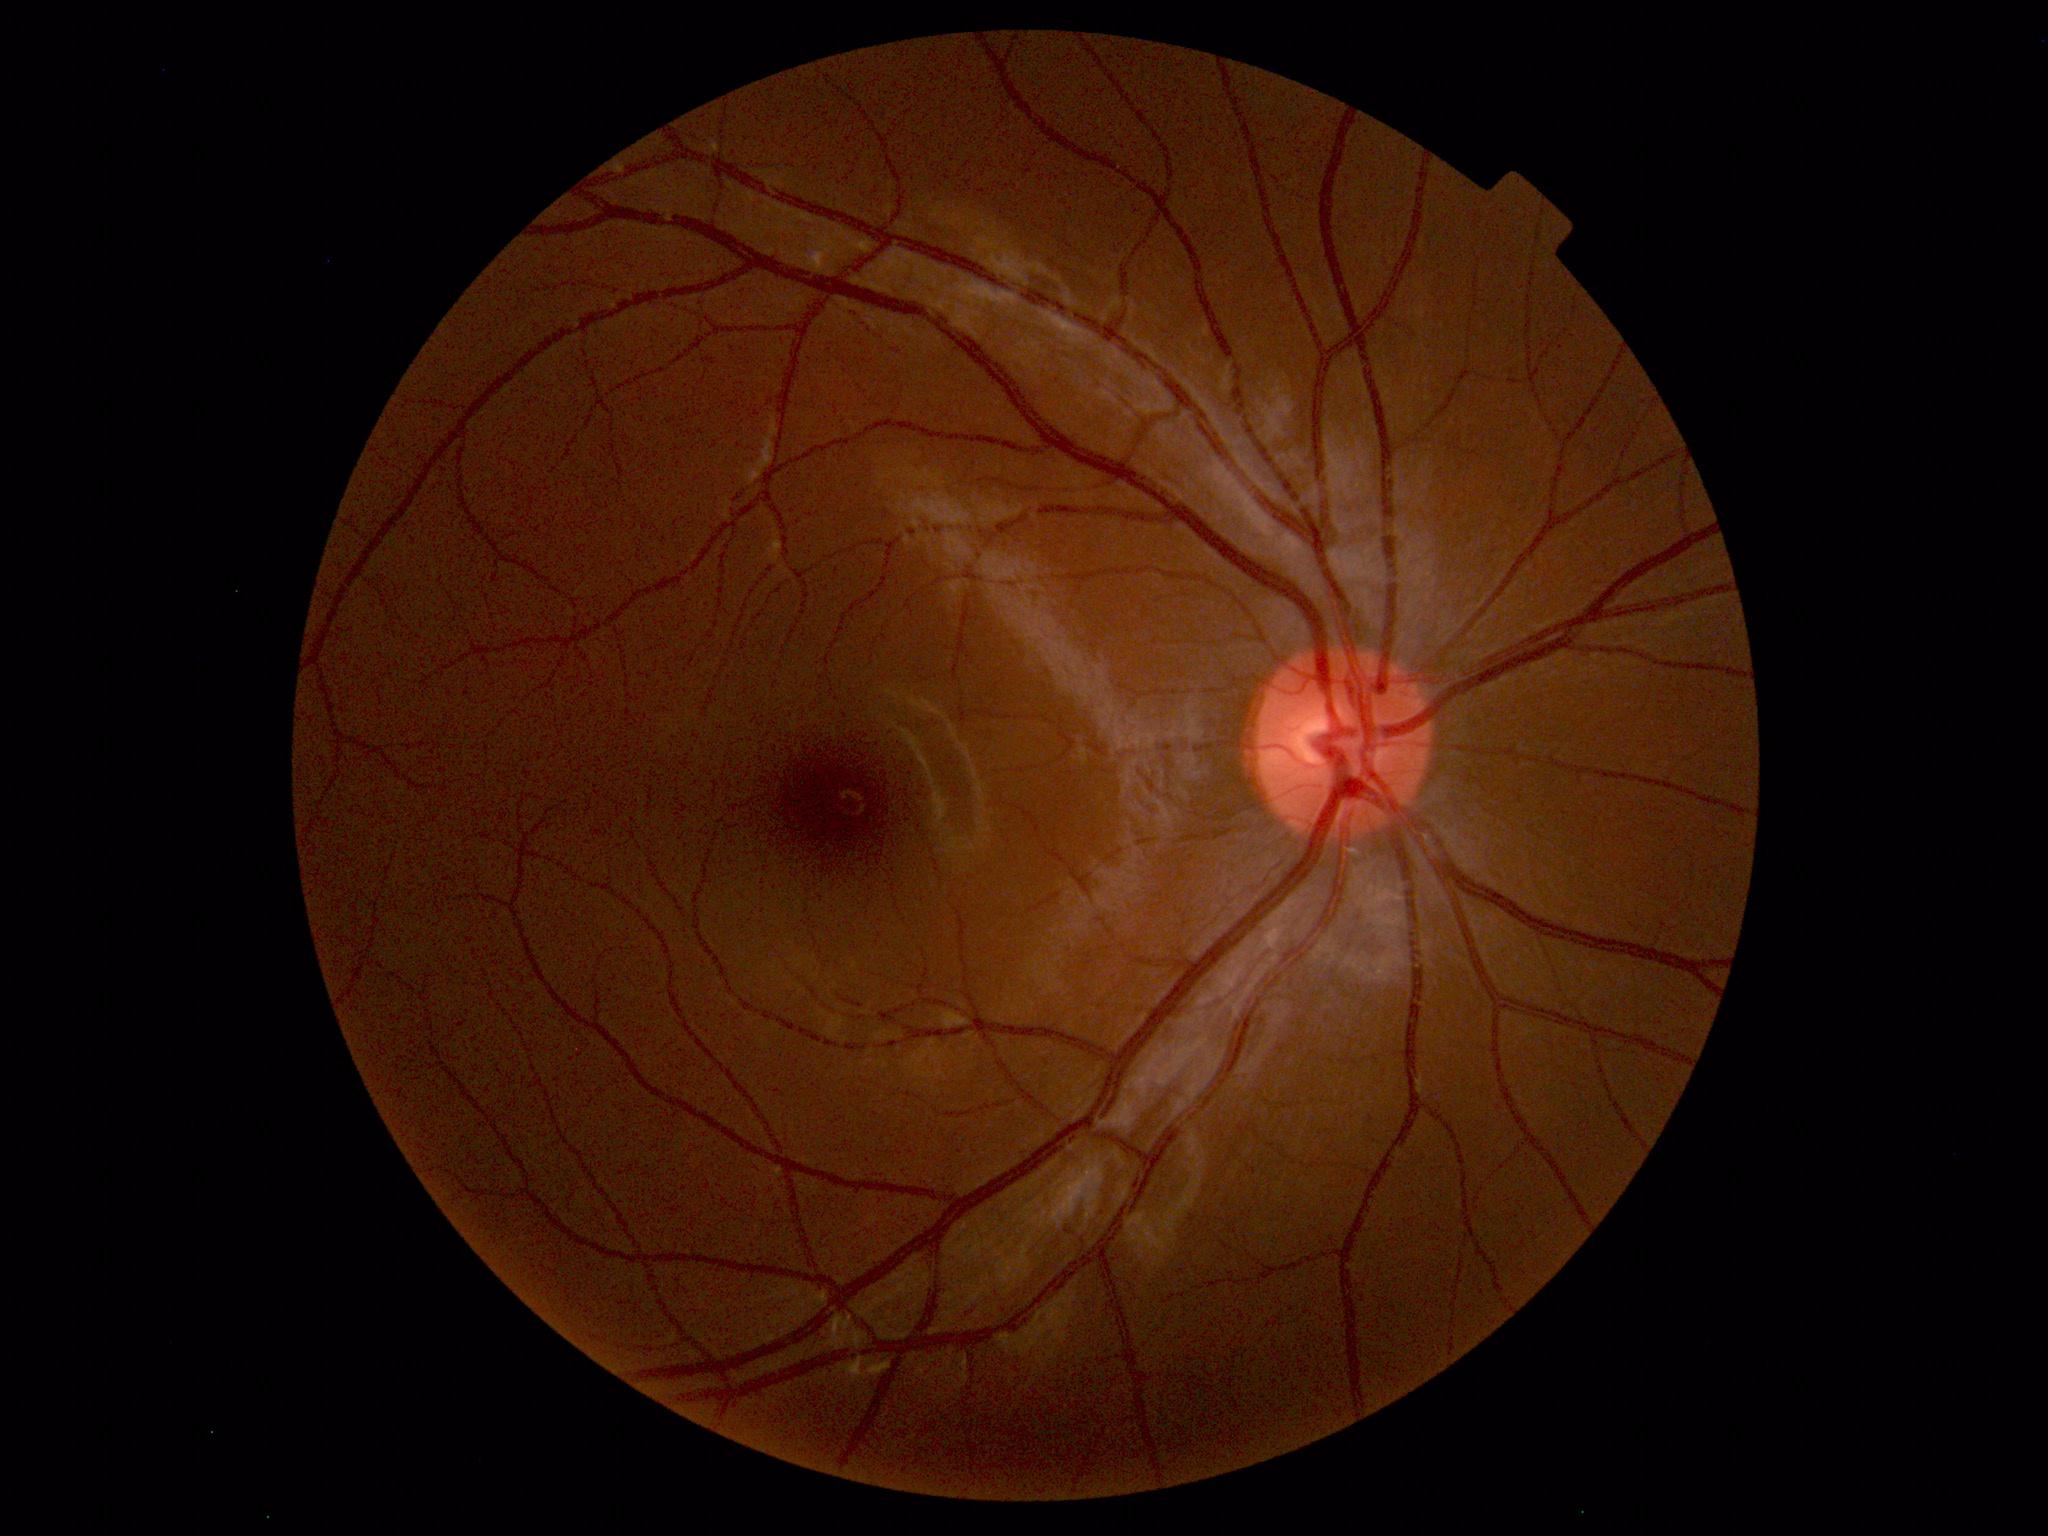
Impression: within normal limits.